Acquired with a Nidek AFC-330. Non-mydriatic
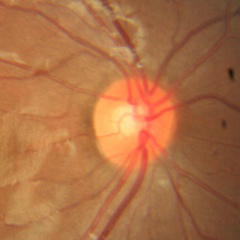

Fundus image with findings of no evidence of glaucoma.